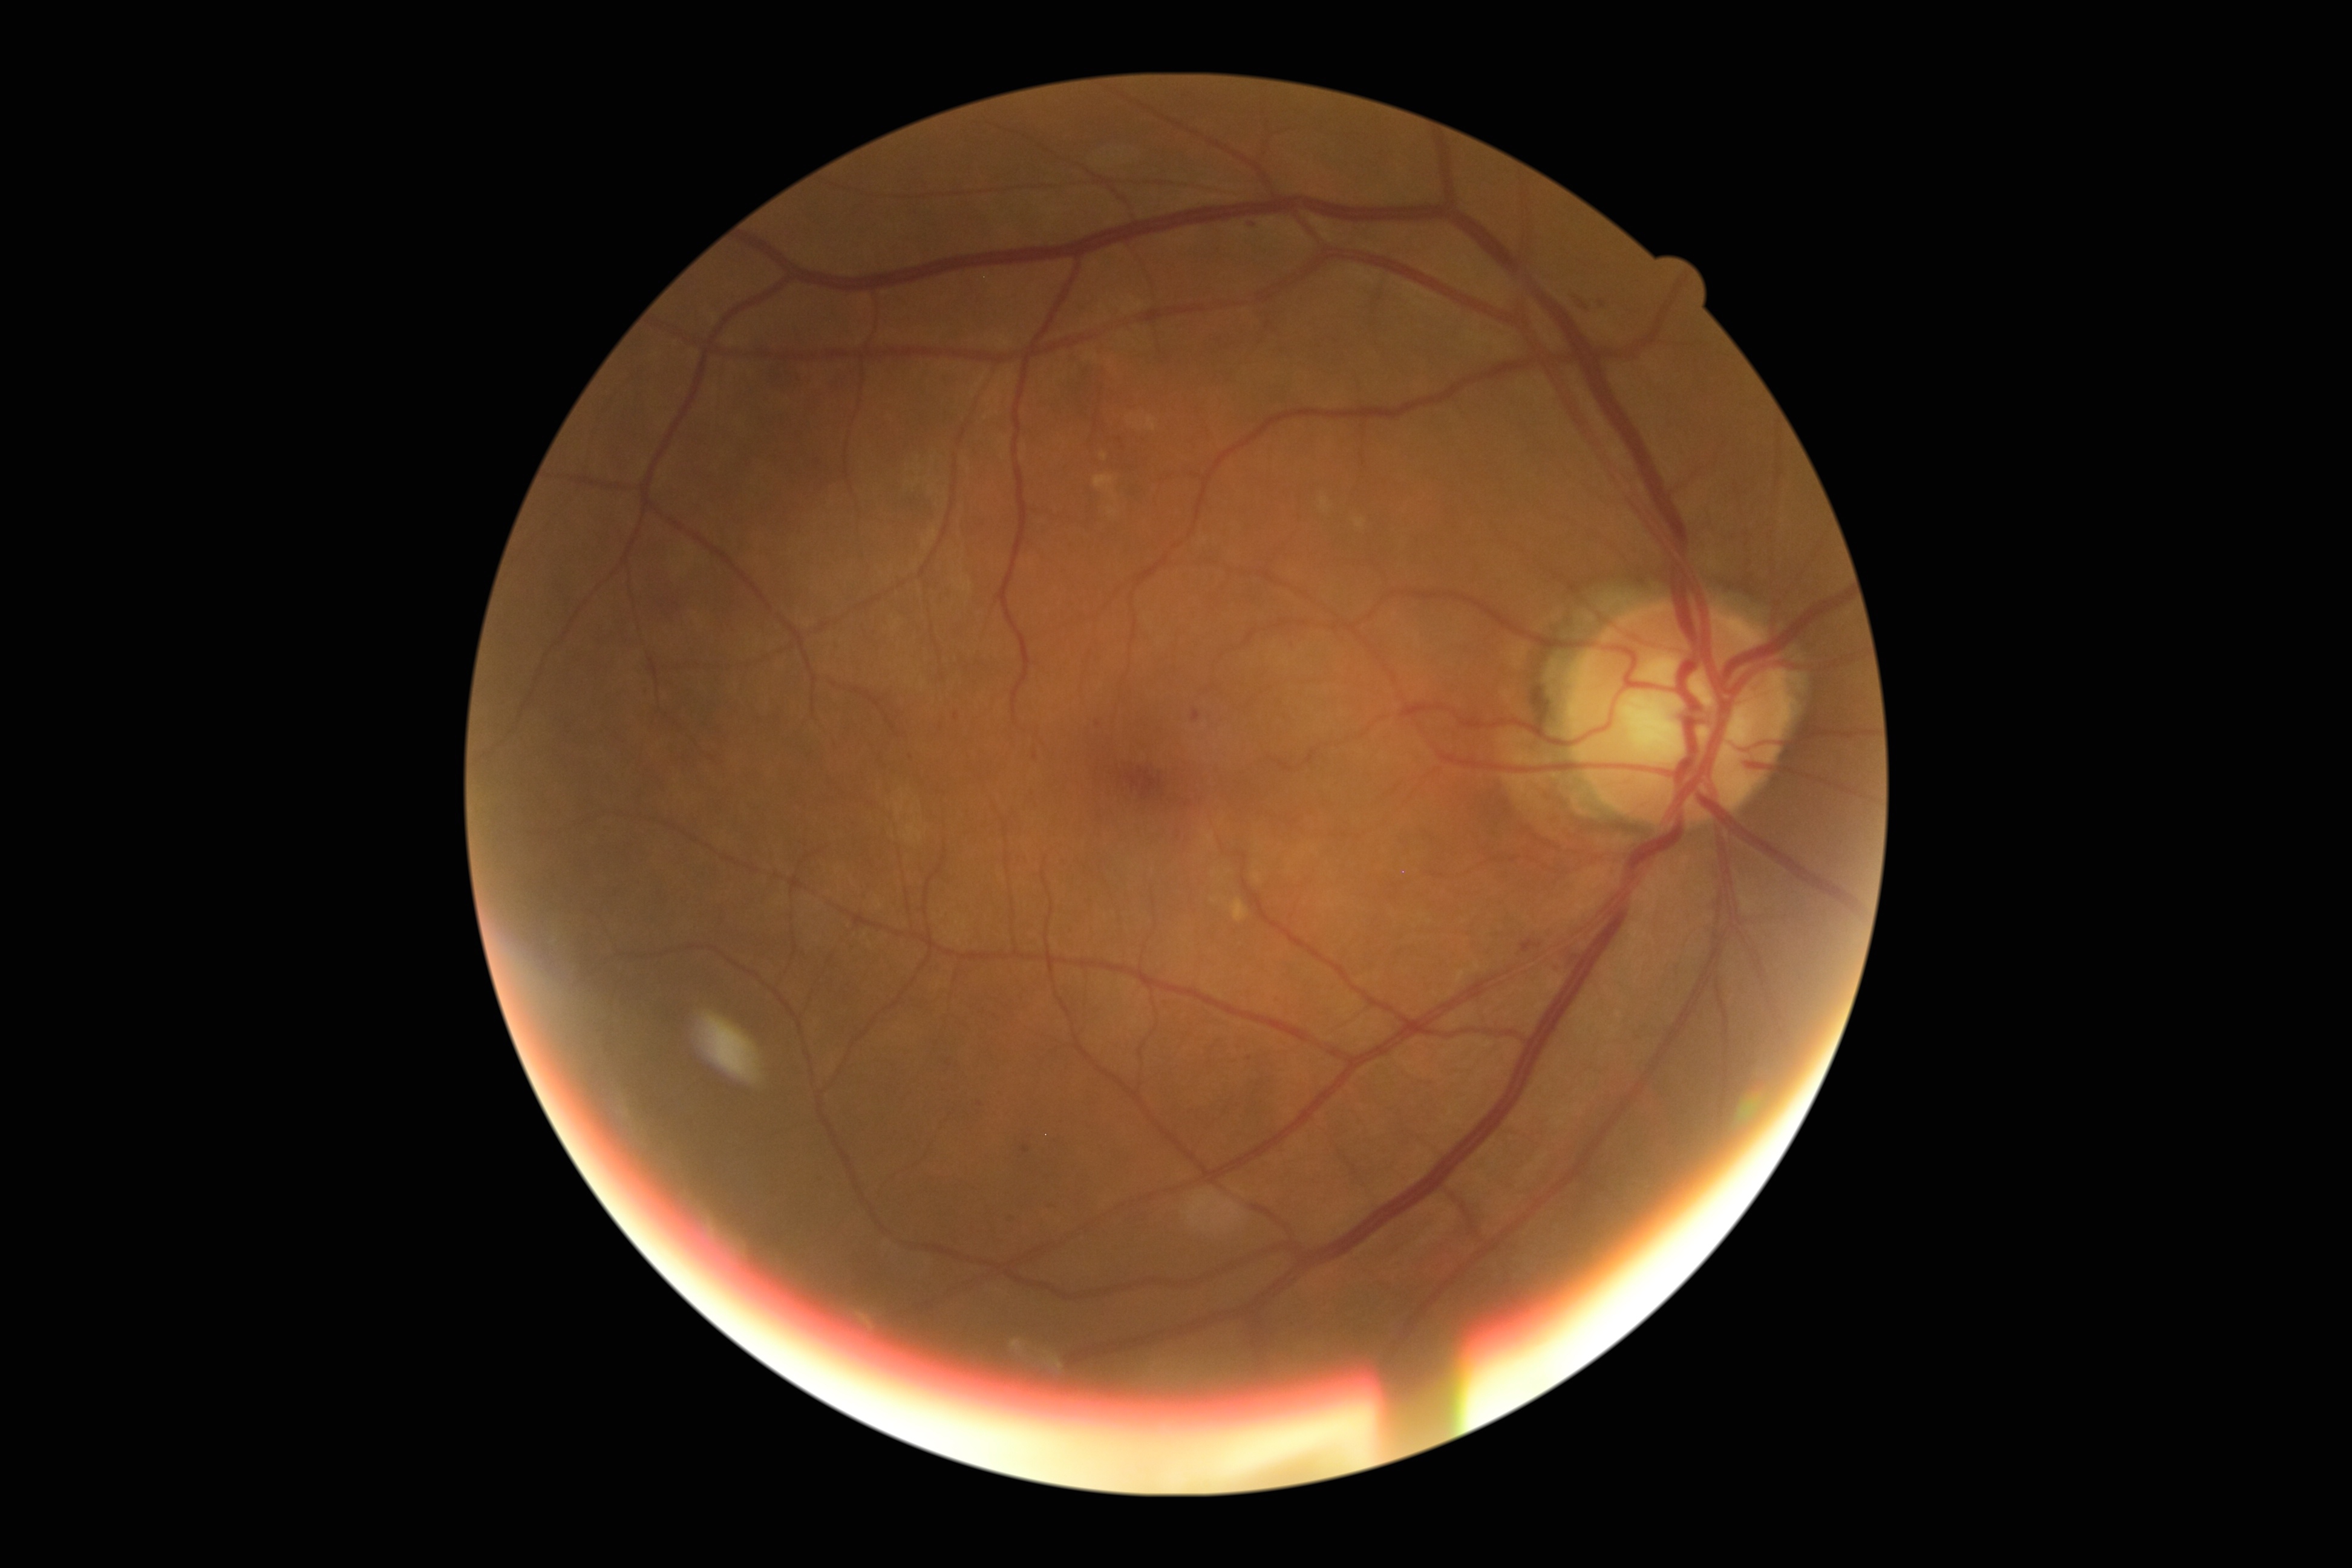 diabetic retinopathy severity: grade 2 (moderate NPDR) | DR class: non-proliferative diabetic retinopathy.